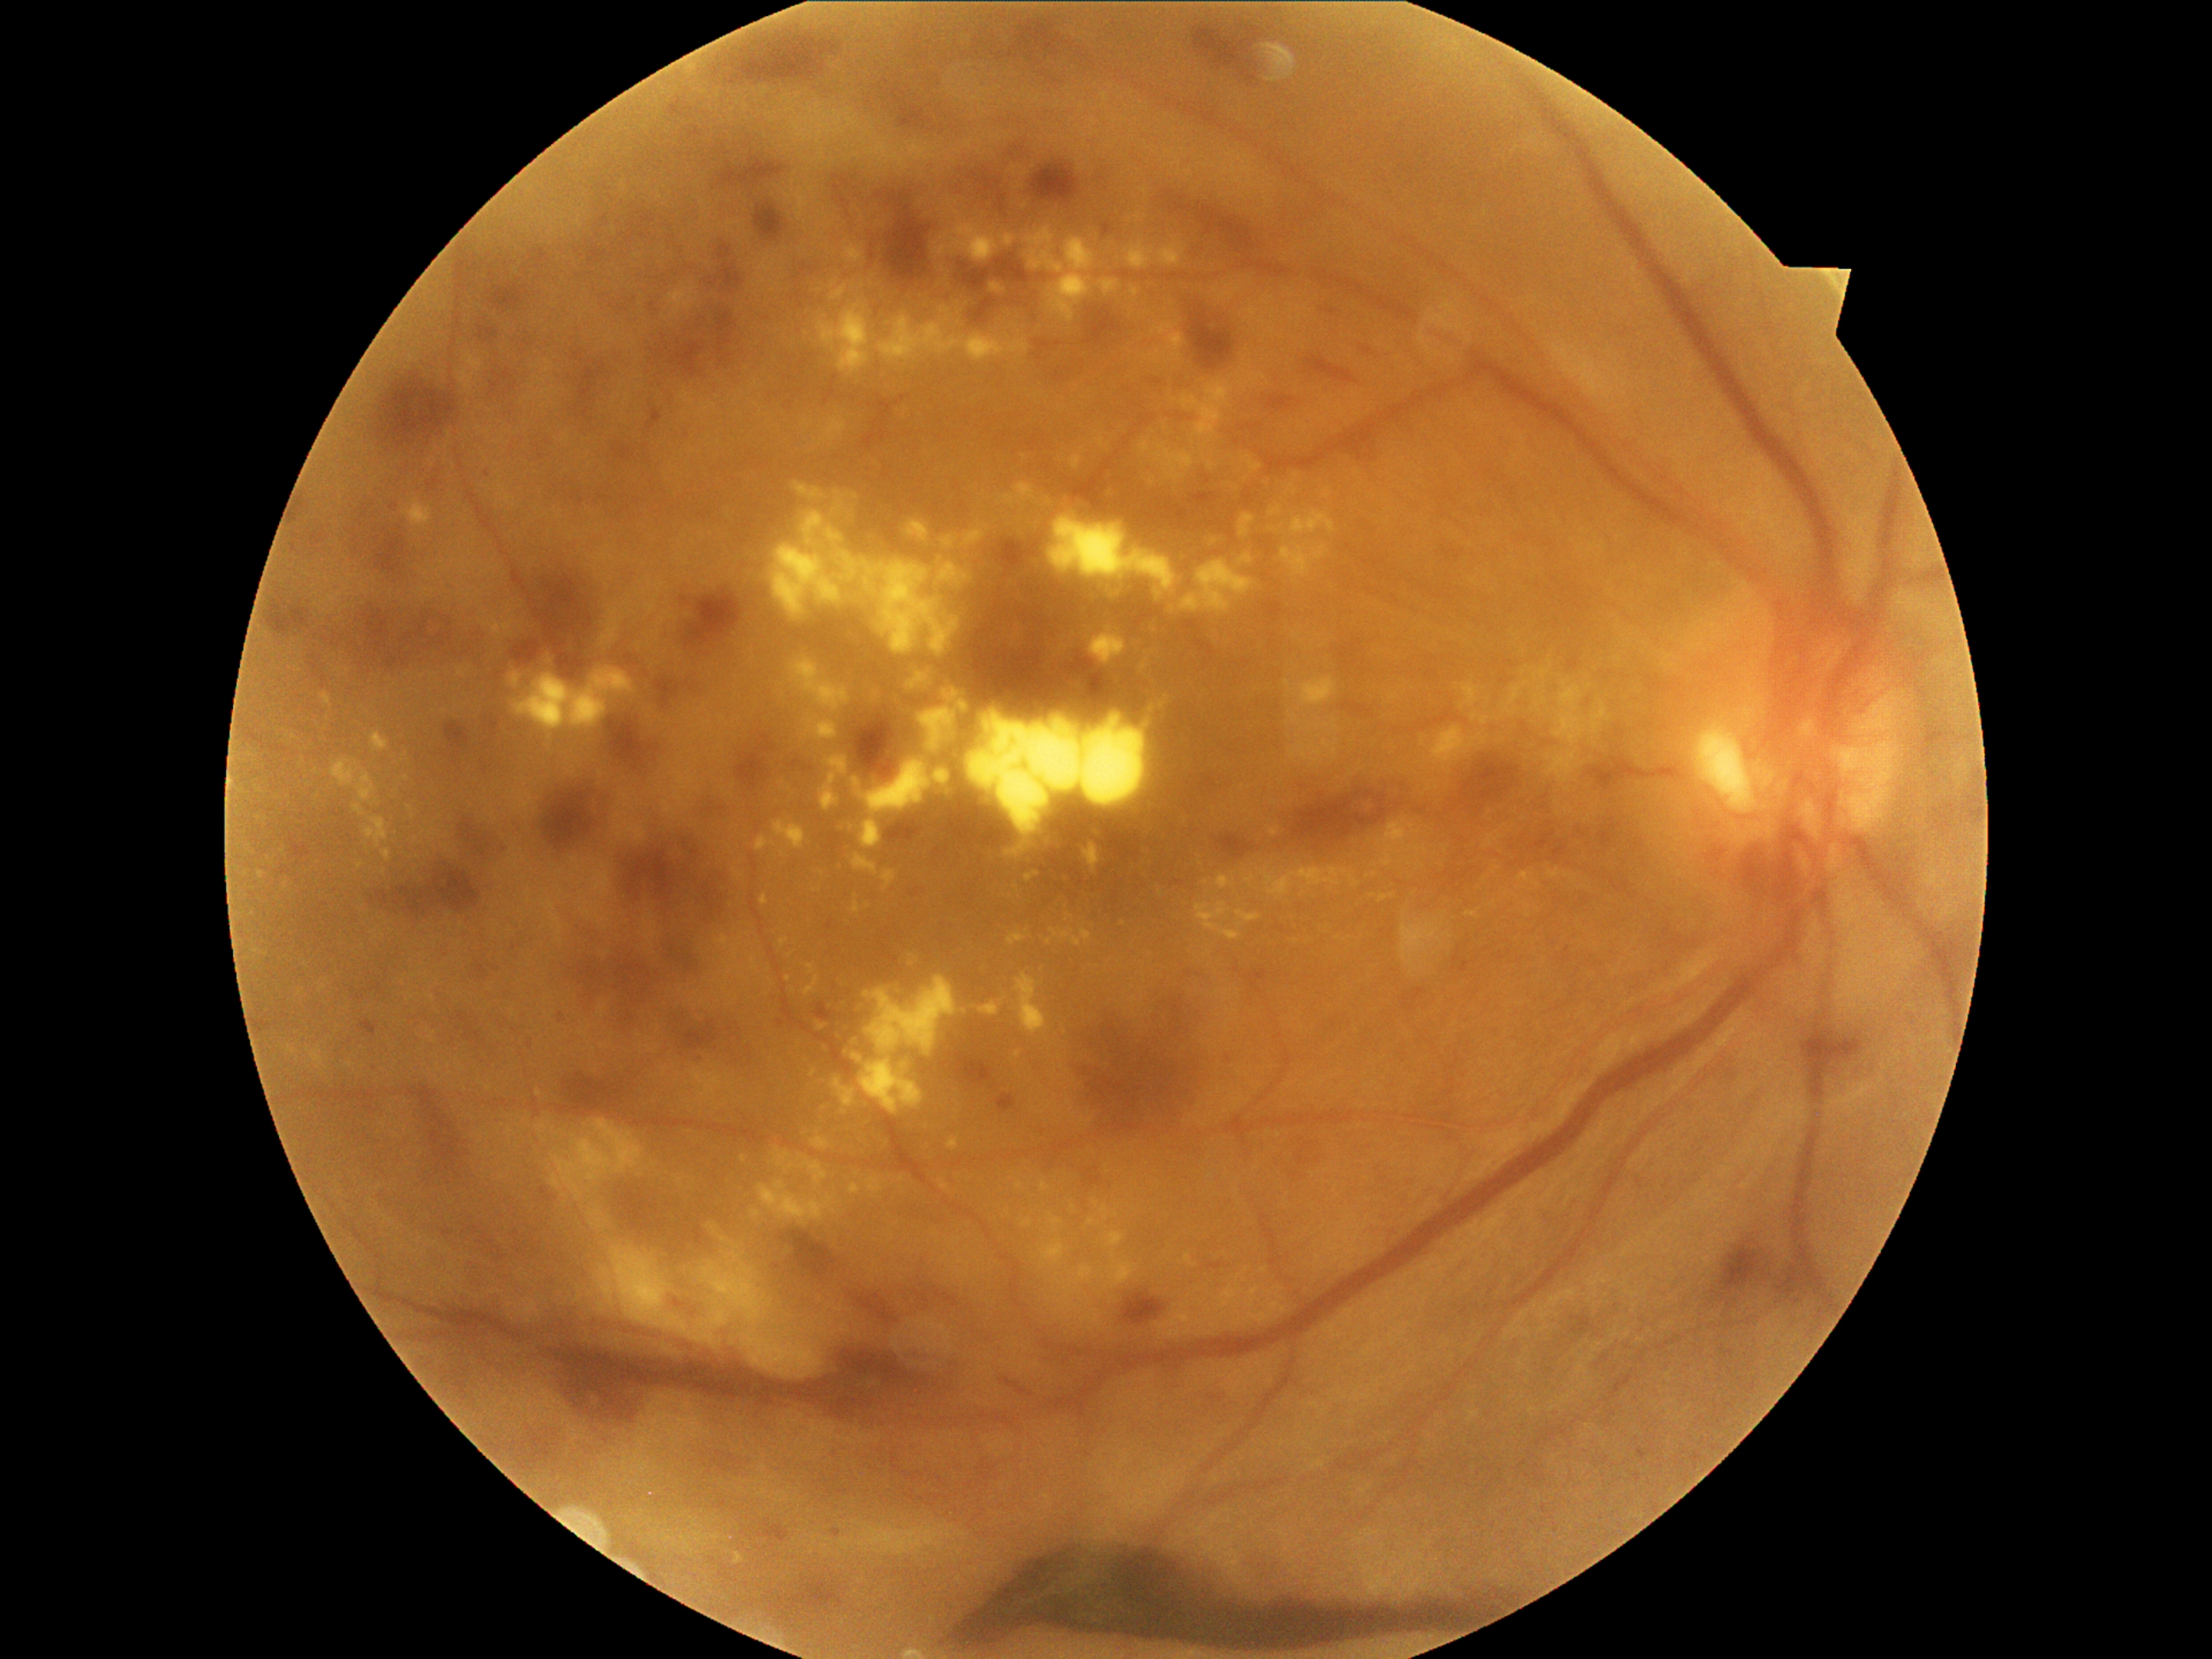
partial: true
dr_grade: 4
lesions:
  ex:
    - box=[1400, 924, 1443, 967]
    - box=[670, 289, 697, 315]
    - box=[1339, 409, 1346, 417]
    - box=[1486, 835, 1496, 846]
    - box=[509, 672, 523, 690]
    - box=[1100, 1206, 1110, 1220]
    - box=[1327, 491, 1332, 499]
    - box=[1001, 235, 1016, 247]
    - box=[1172, 383, 1233, 450]
    - box=[1098, 279, 1122, 296]
    - box=[774, 820, 806, 849]
    - box=[873, 692, 880, 704]
    - box=[1216, 875, 1237, 890]
  ex_small_centers:
    - [432,999]
    - [1194,1325]
    - [302,763]
    - [1496,868]
    - [955,694]
    - [1117,1215]
    - [1297,477]